1440 by 1080 pixels. Natus RetCam Envision, 130° FOV. Infant wide-field retinal image
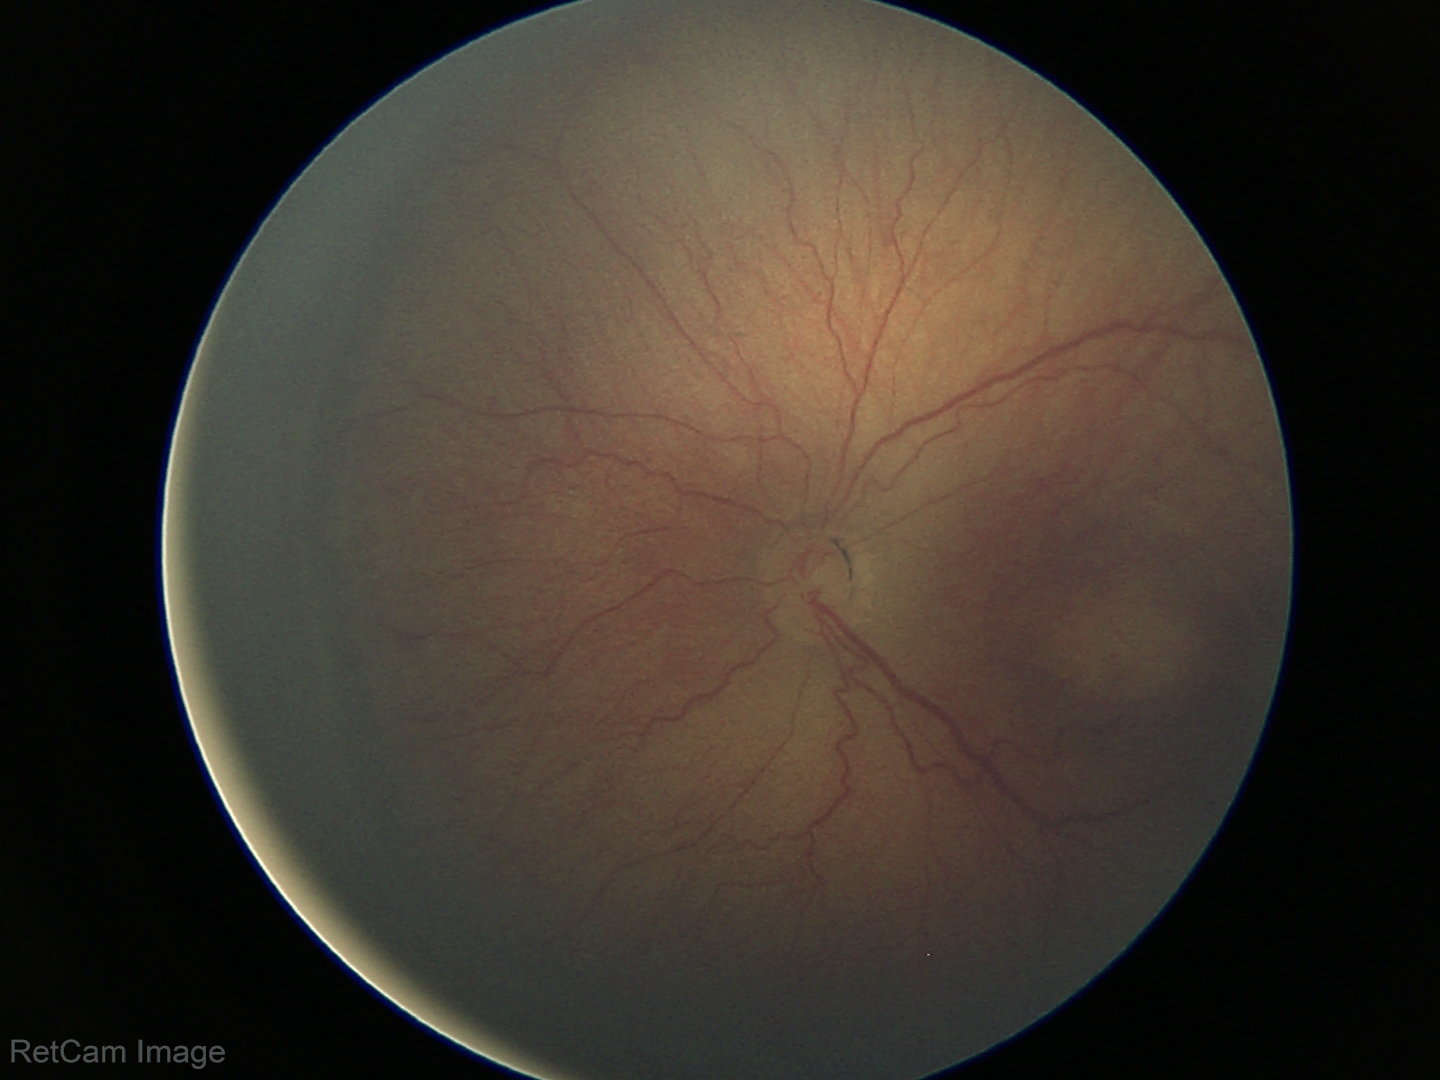 Screening diagnosis: retinopathy of prematurity stage 3 — ridge with extraretinal fibrovascular proliferation.